FOV: 45 degrees — 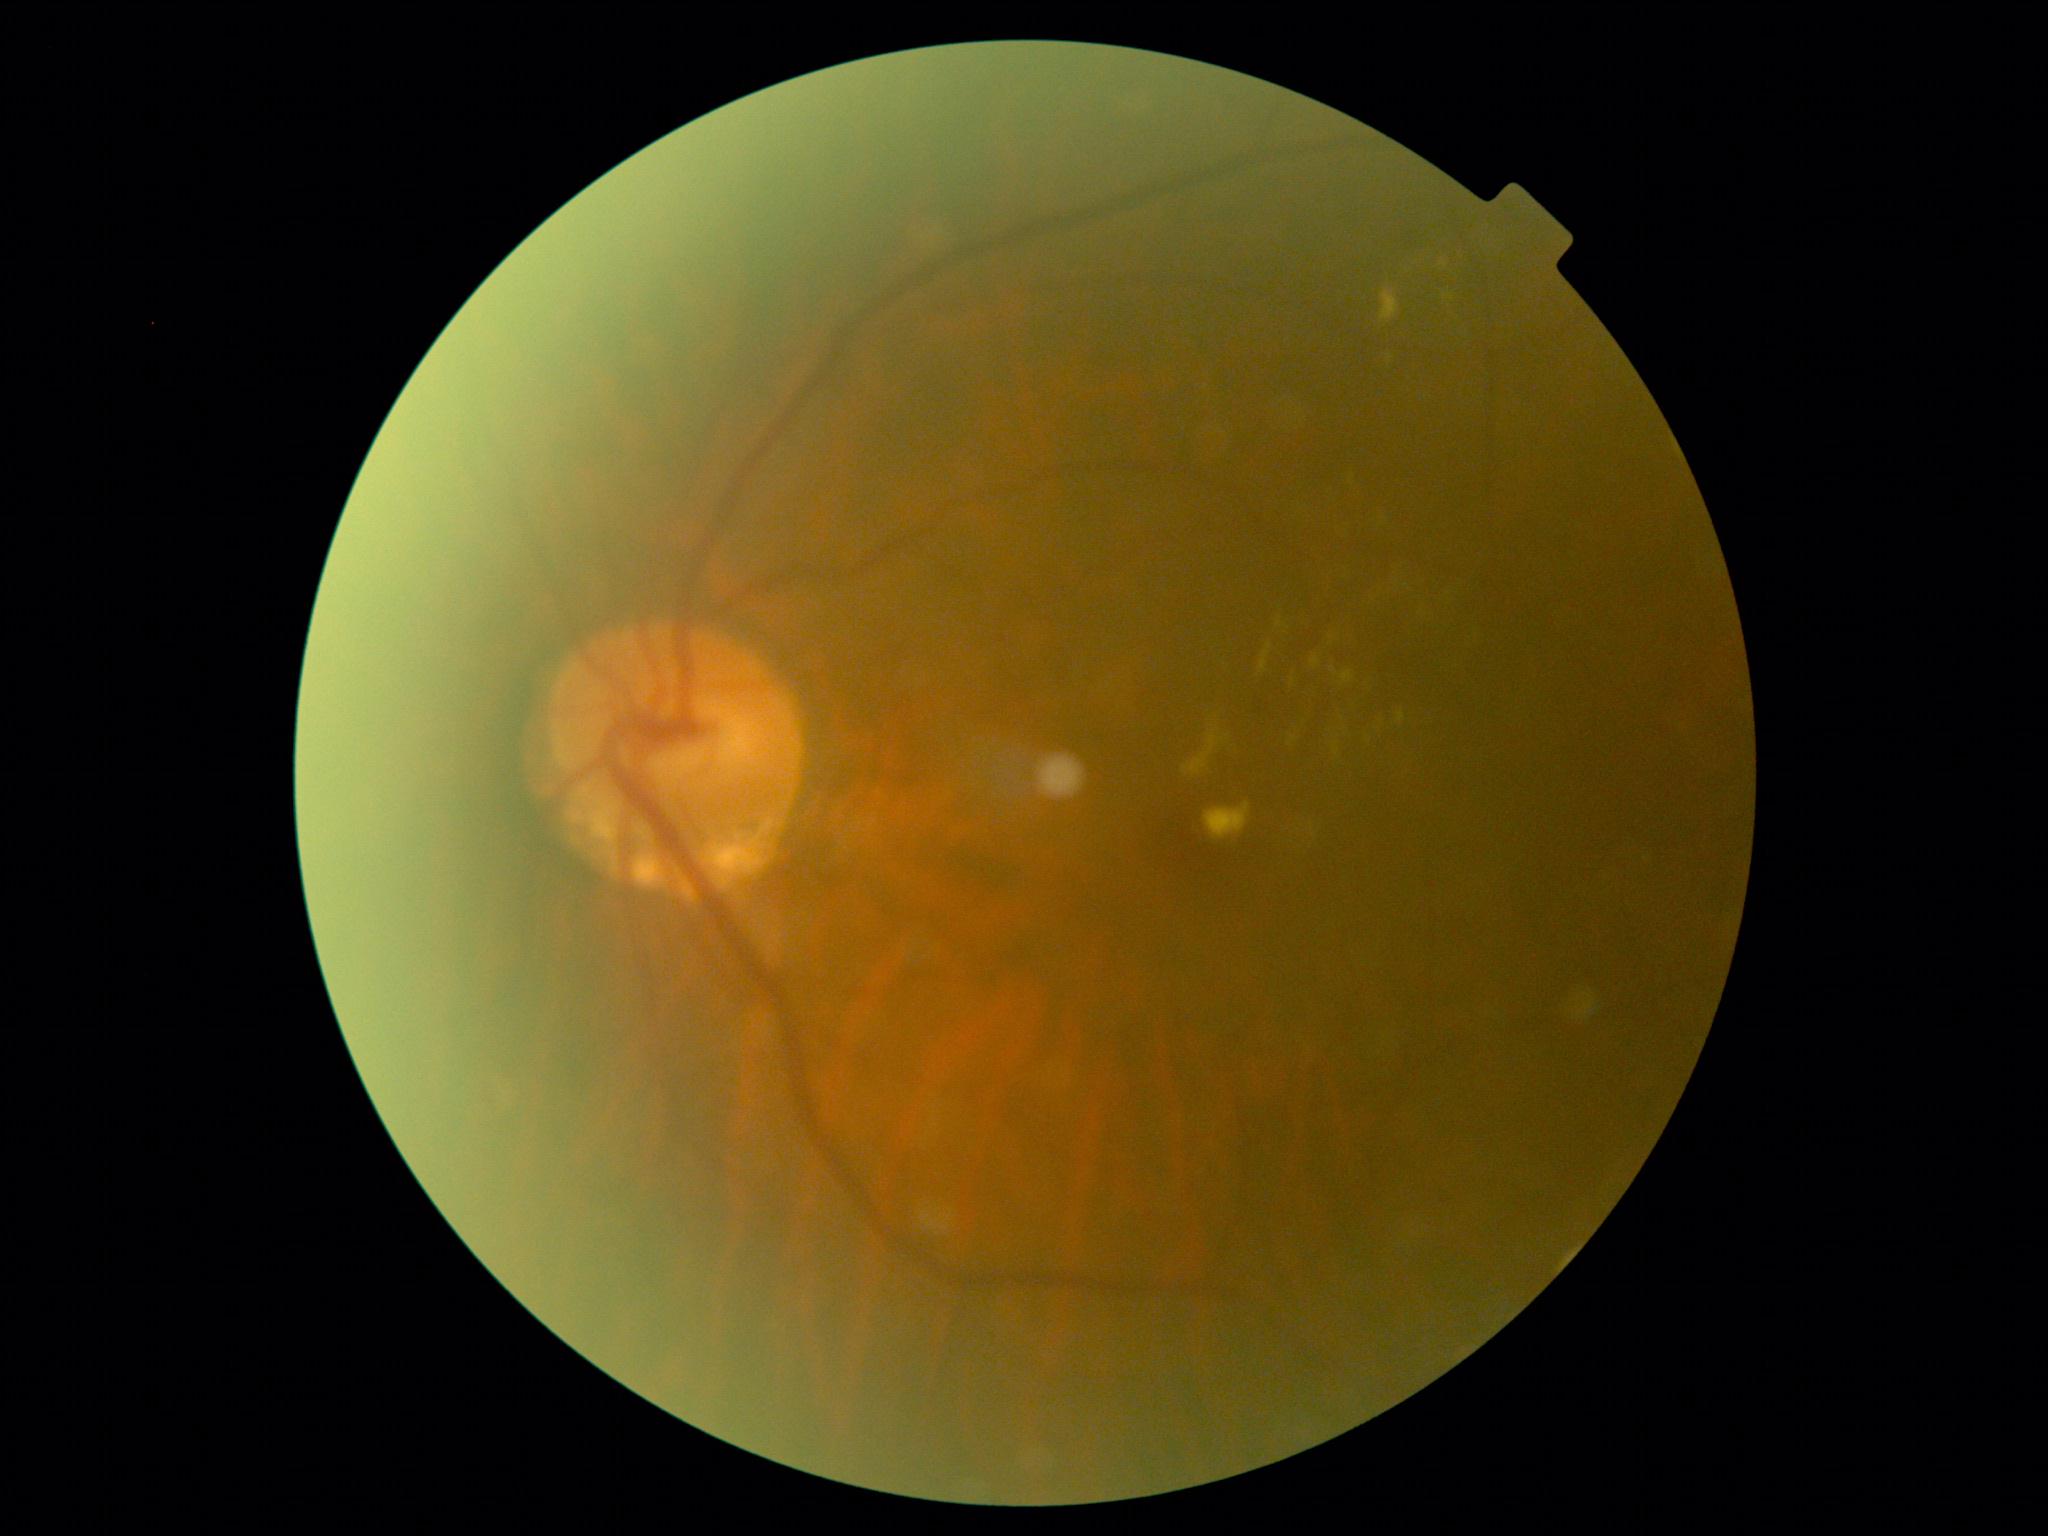
DR stage is 2.